RetCam wide-field infant fundus image — 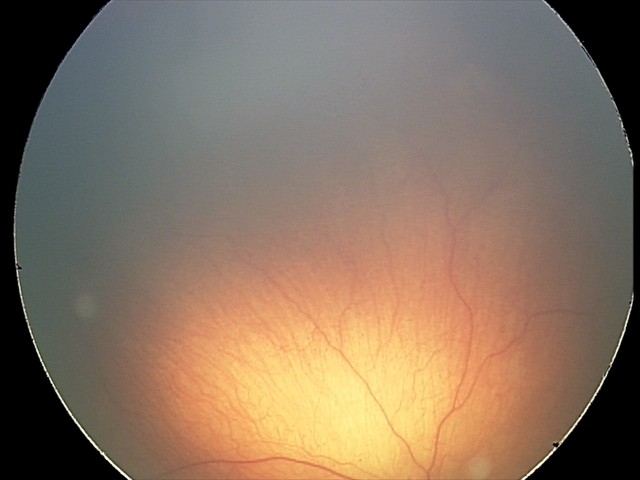
Diagnosis from this screening exam: retinopathy of prematurity stage 2.
Without plus disease.